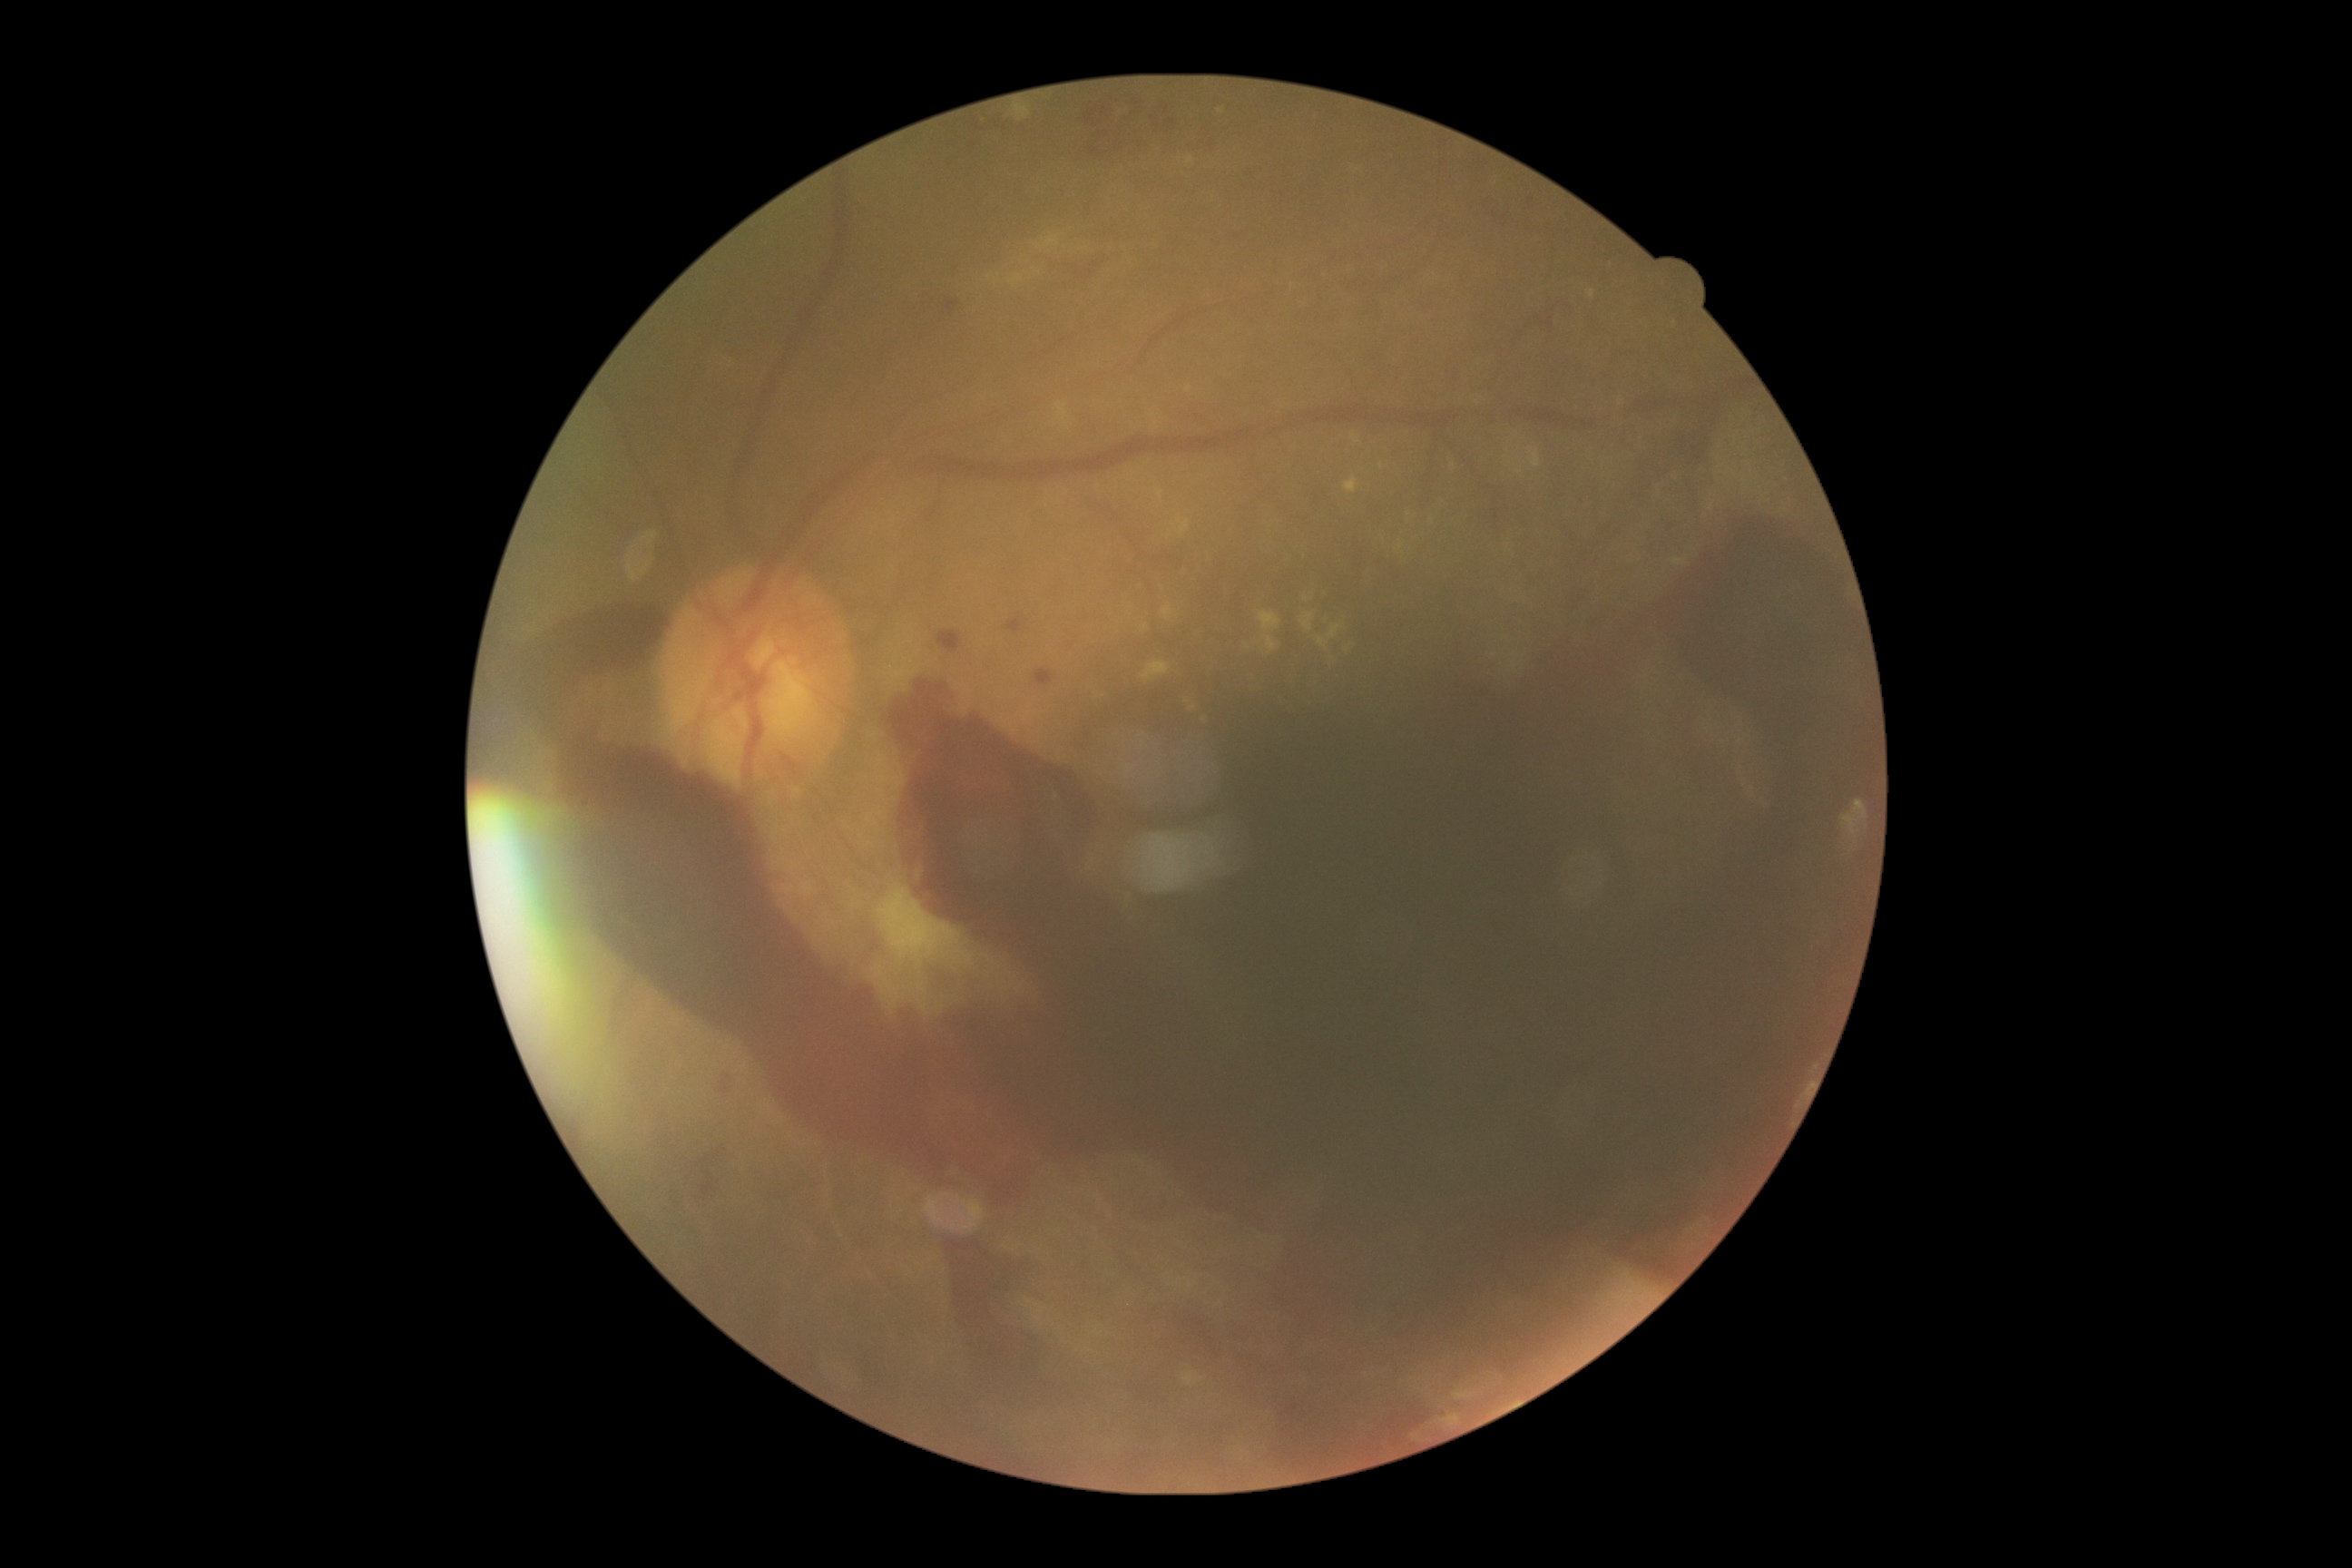 Diabetic retinopathy (DR) is PDR (grade 4) — neovascularization and/or vitreous/pre-retinal hemorrhage.